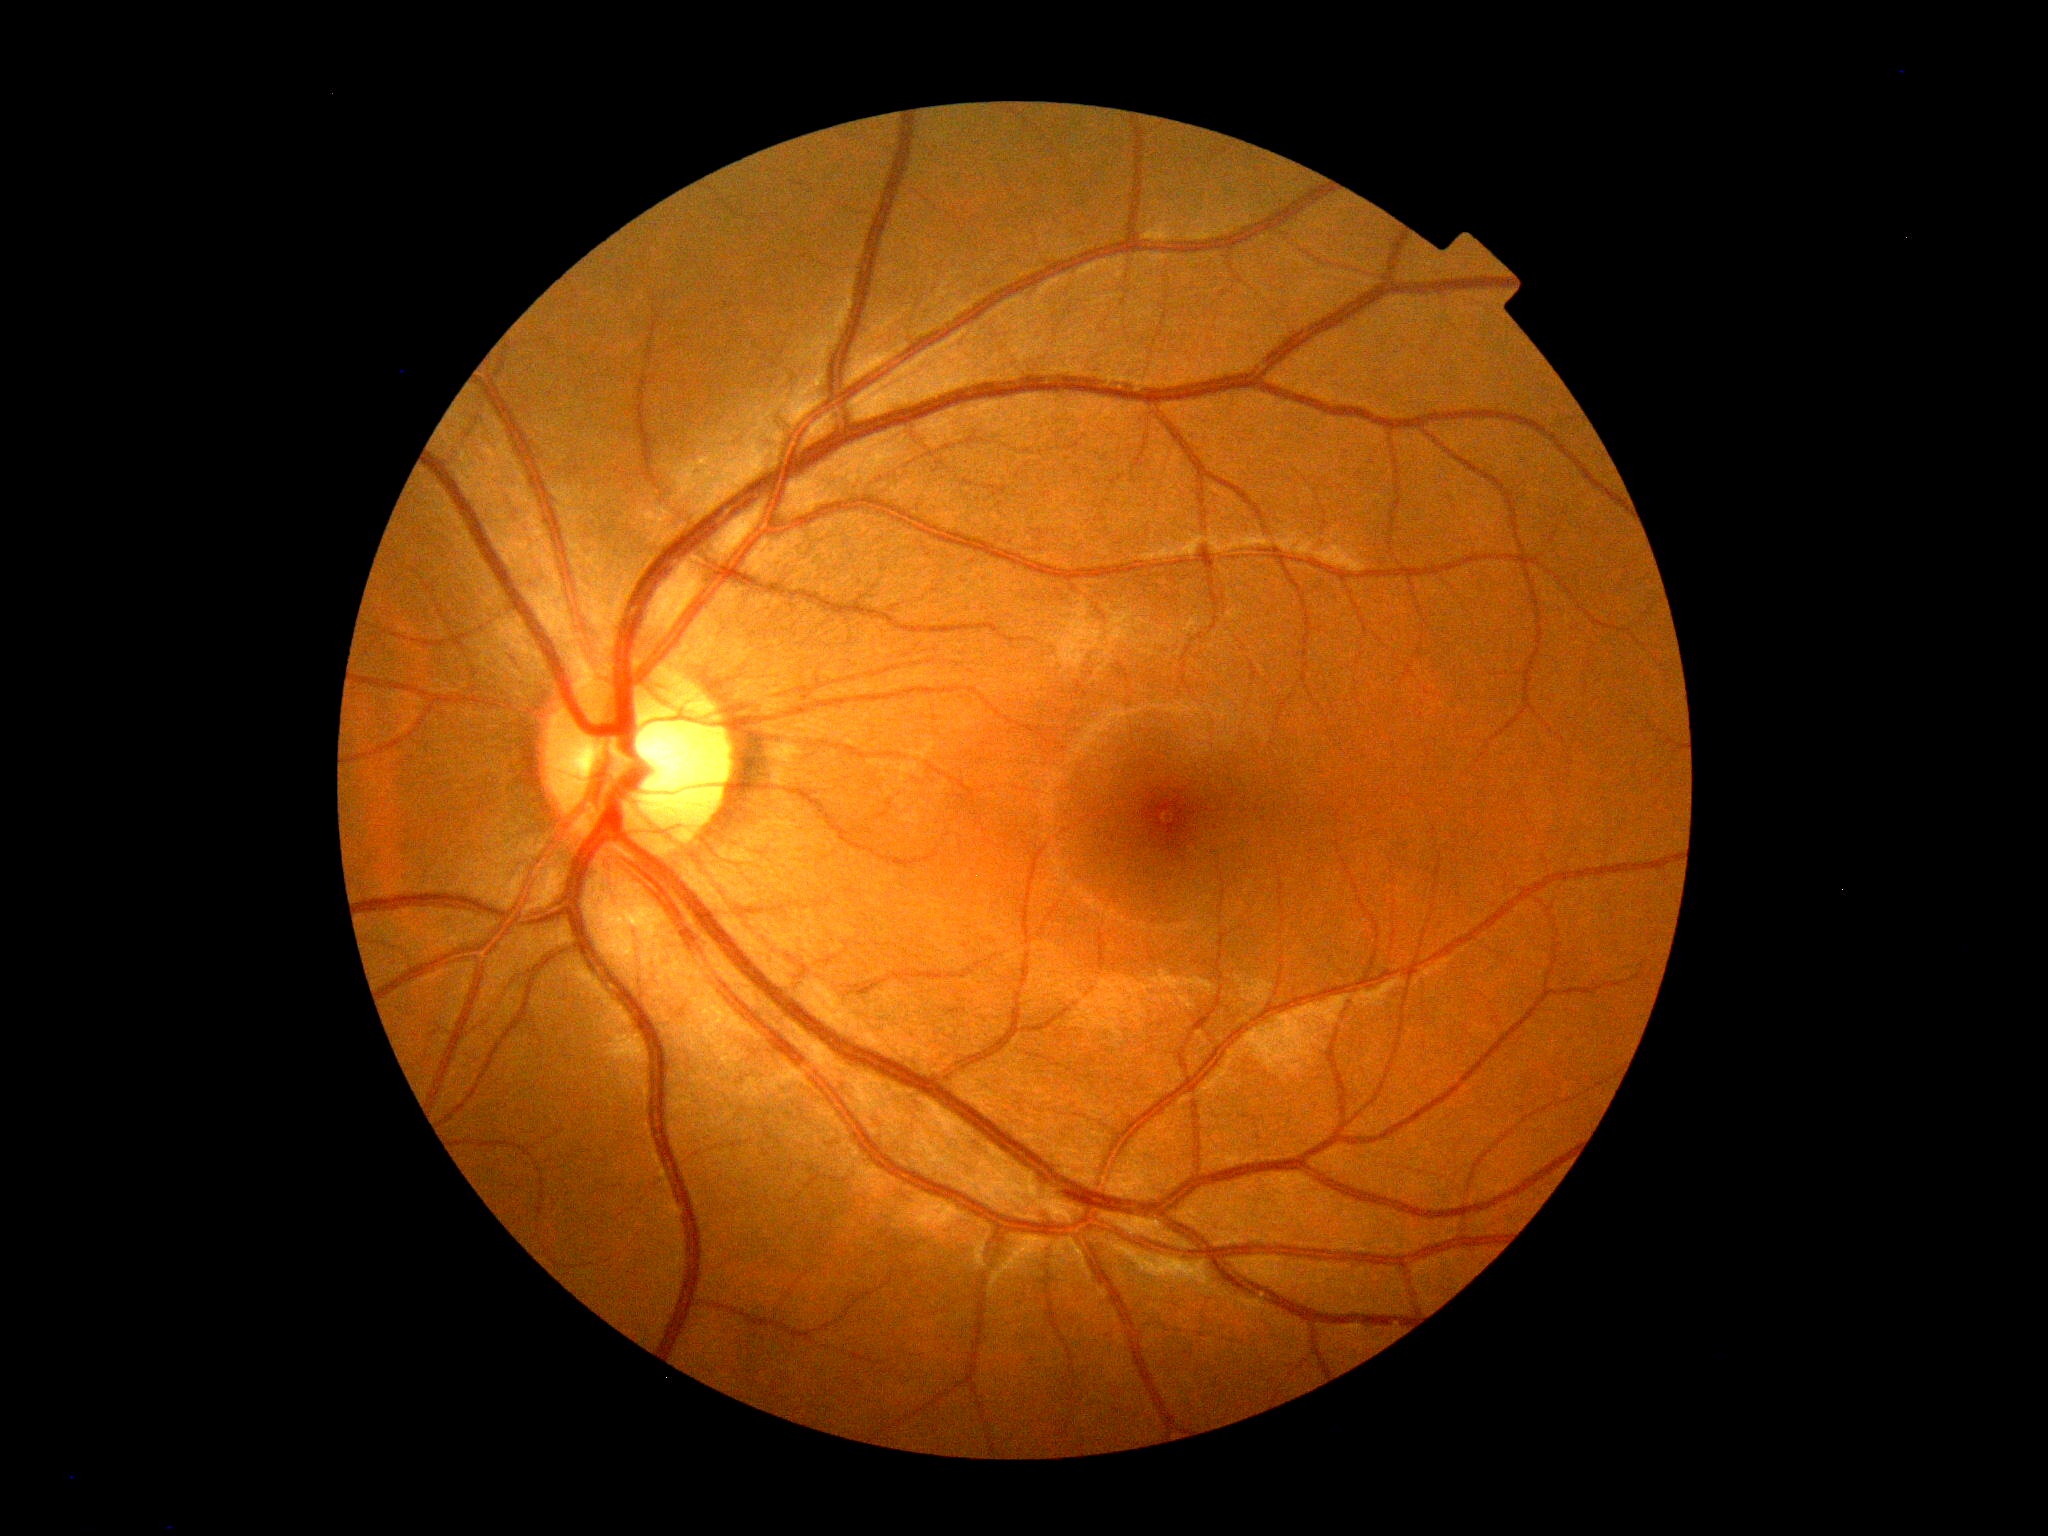
Diabetic retinopathy severity is no apparent retinopathy (grade 0).